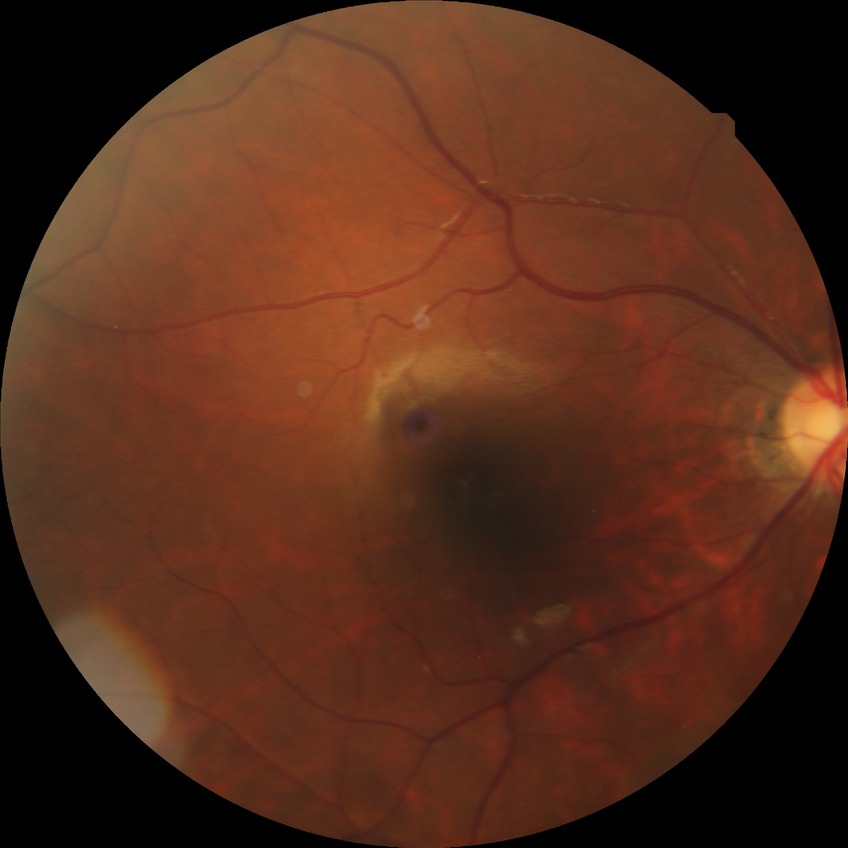

Davis stage is SDR.
The retinopathy is classified as non-proliferative diabetic retinopathy.